Acquired on the Natus RetCam Envision. Infant wide-field retinal image.
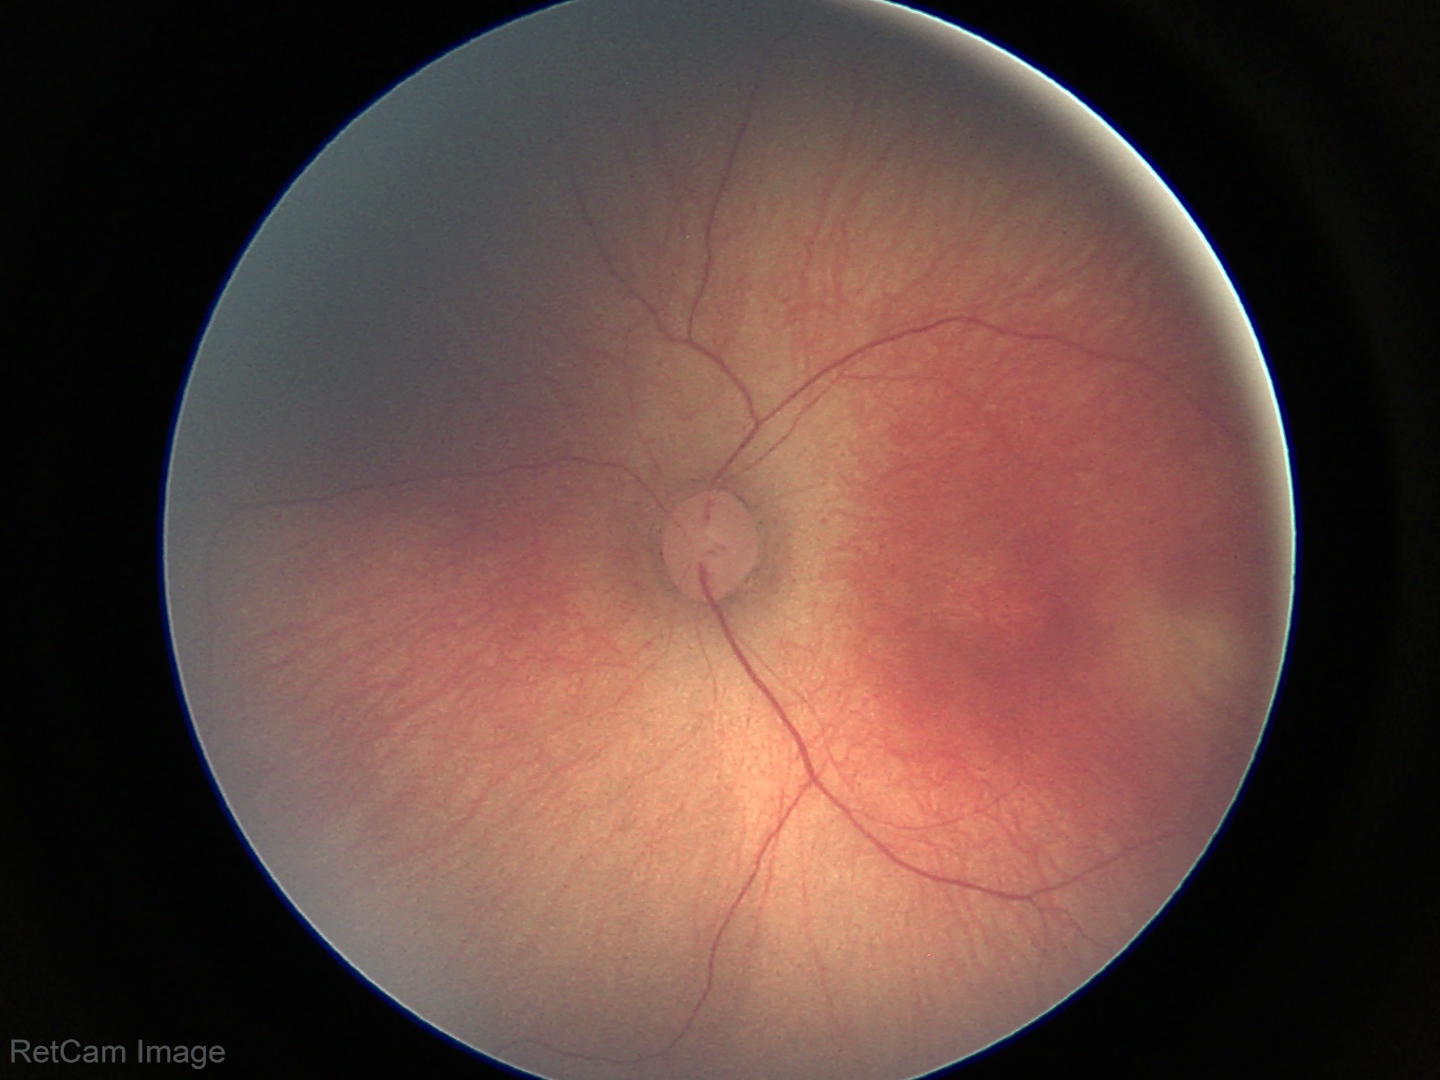 Assessment: no plus disease — posterior pole vessels without abnormal dilation or tortuosity; ROP stage 2.